Pediatric retinal photograph (wide-field) · 1440 x 1080 pixels · camera: Natus RetCam Envision (130° FOV).
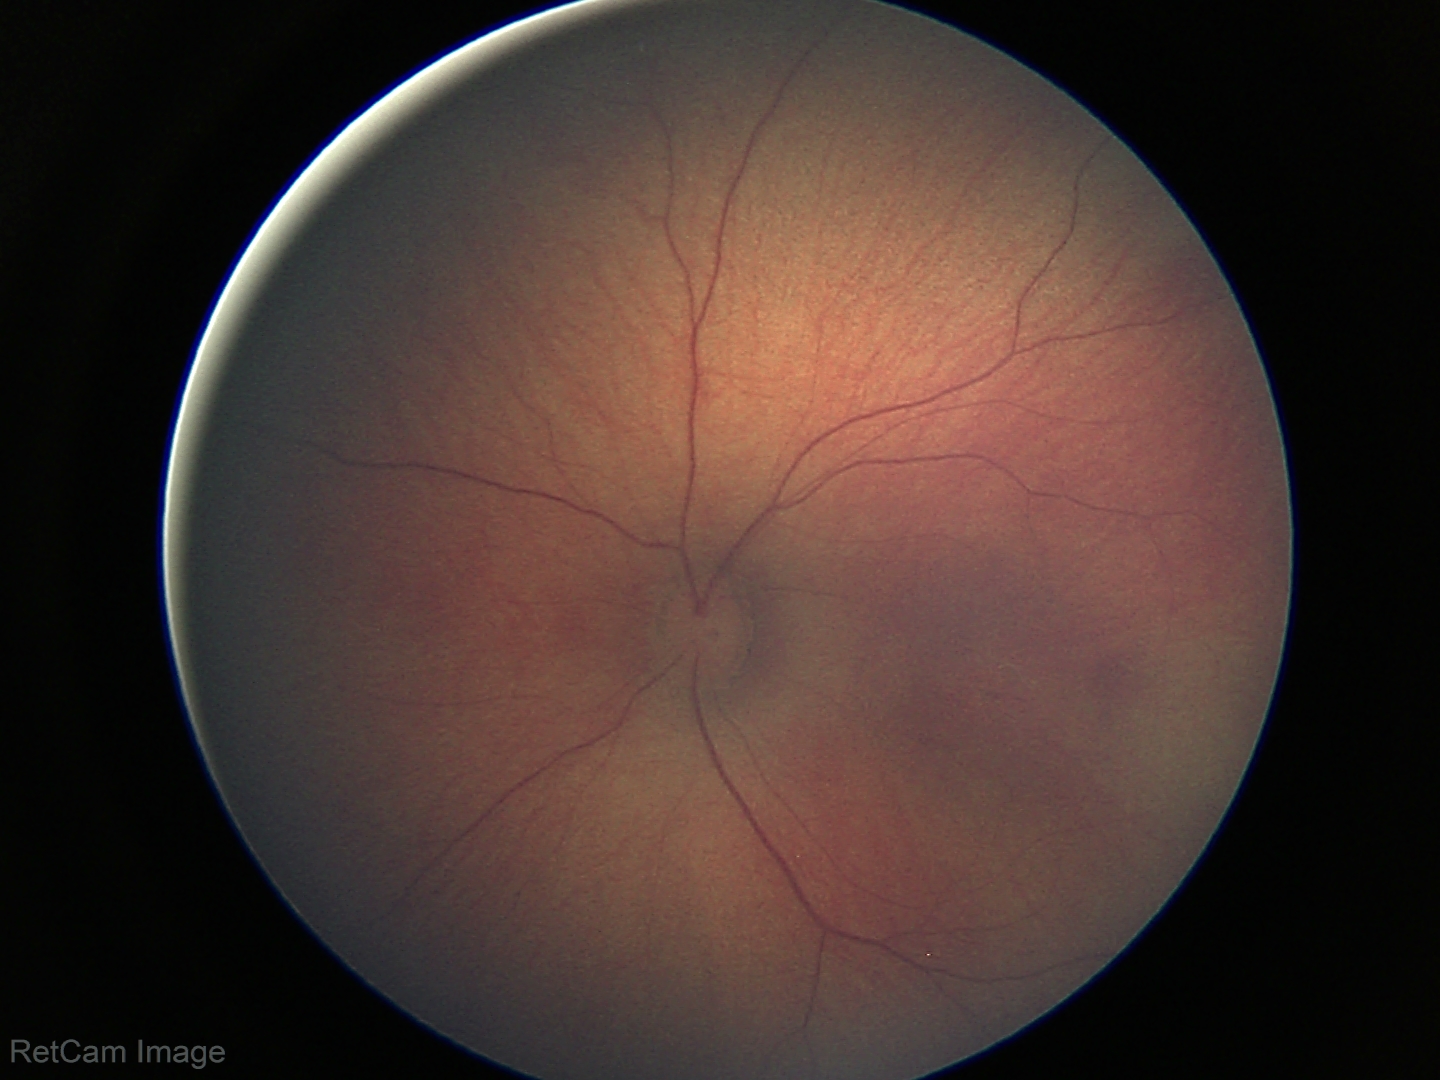 Examination with physiological retinal findings.